Retinal fundus photograph · 45° FOV: 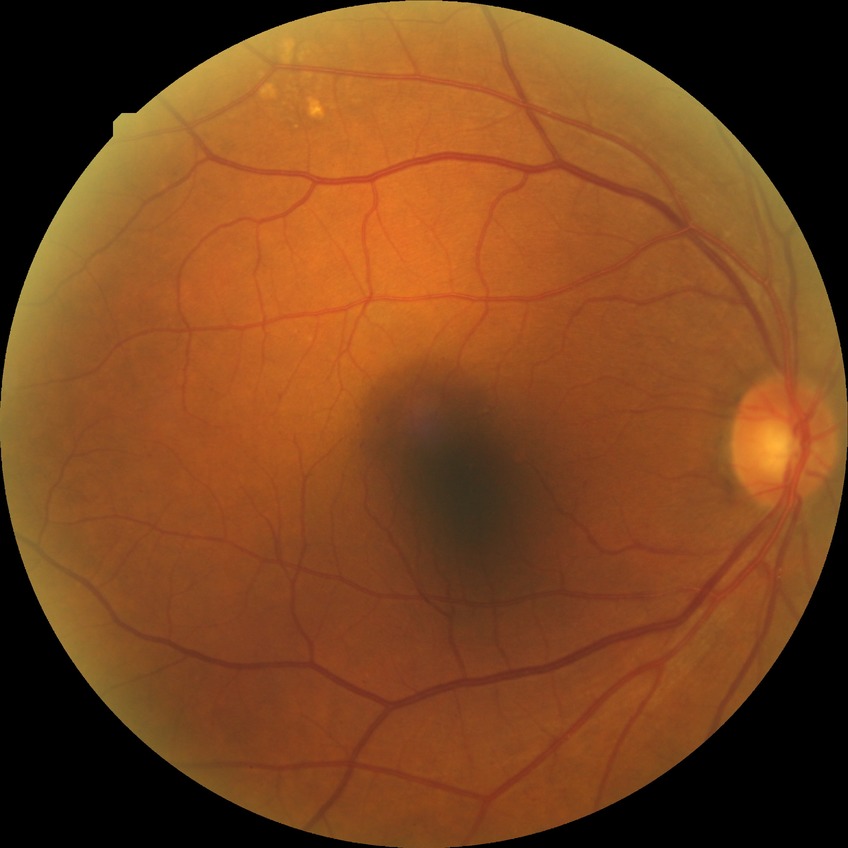
DR: SDR.